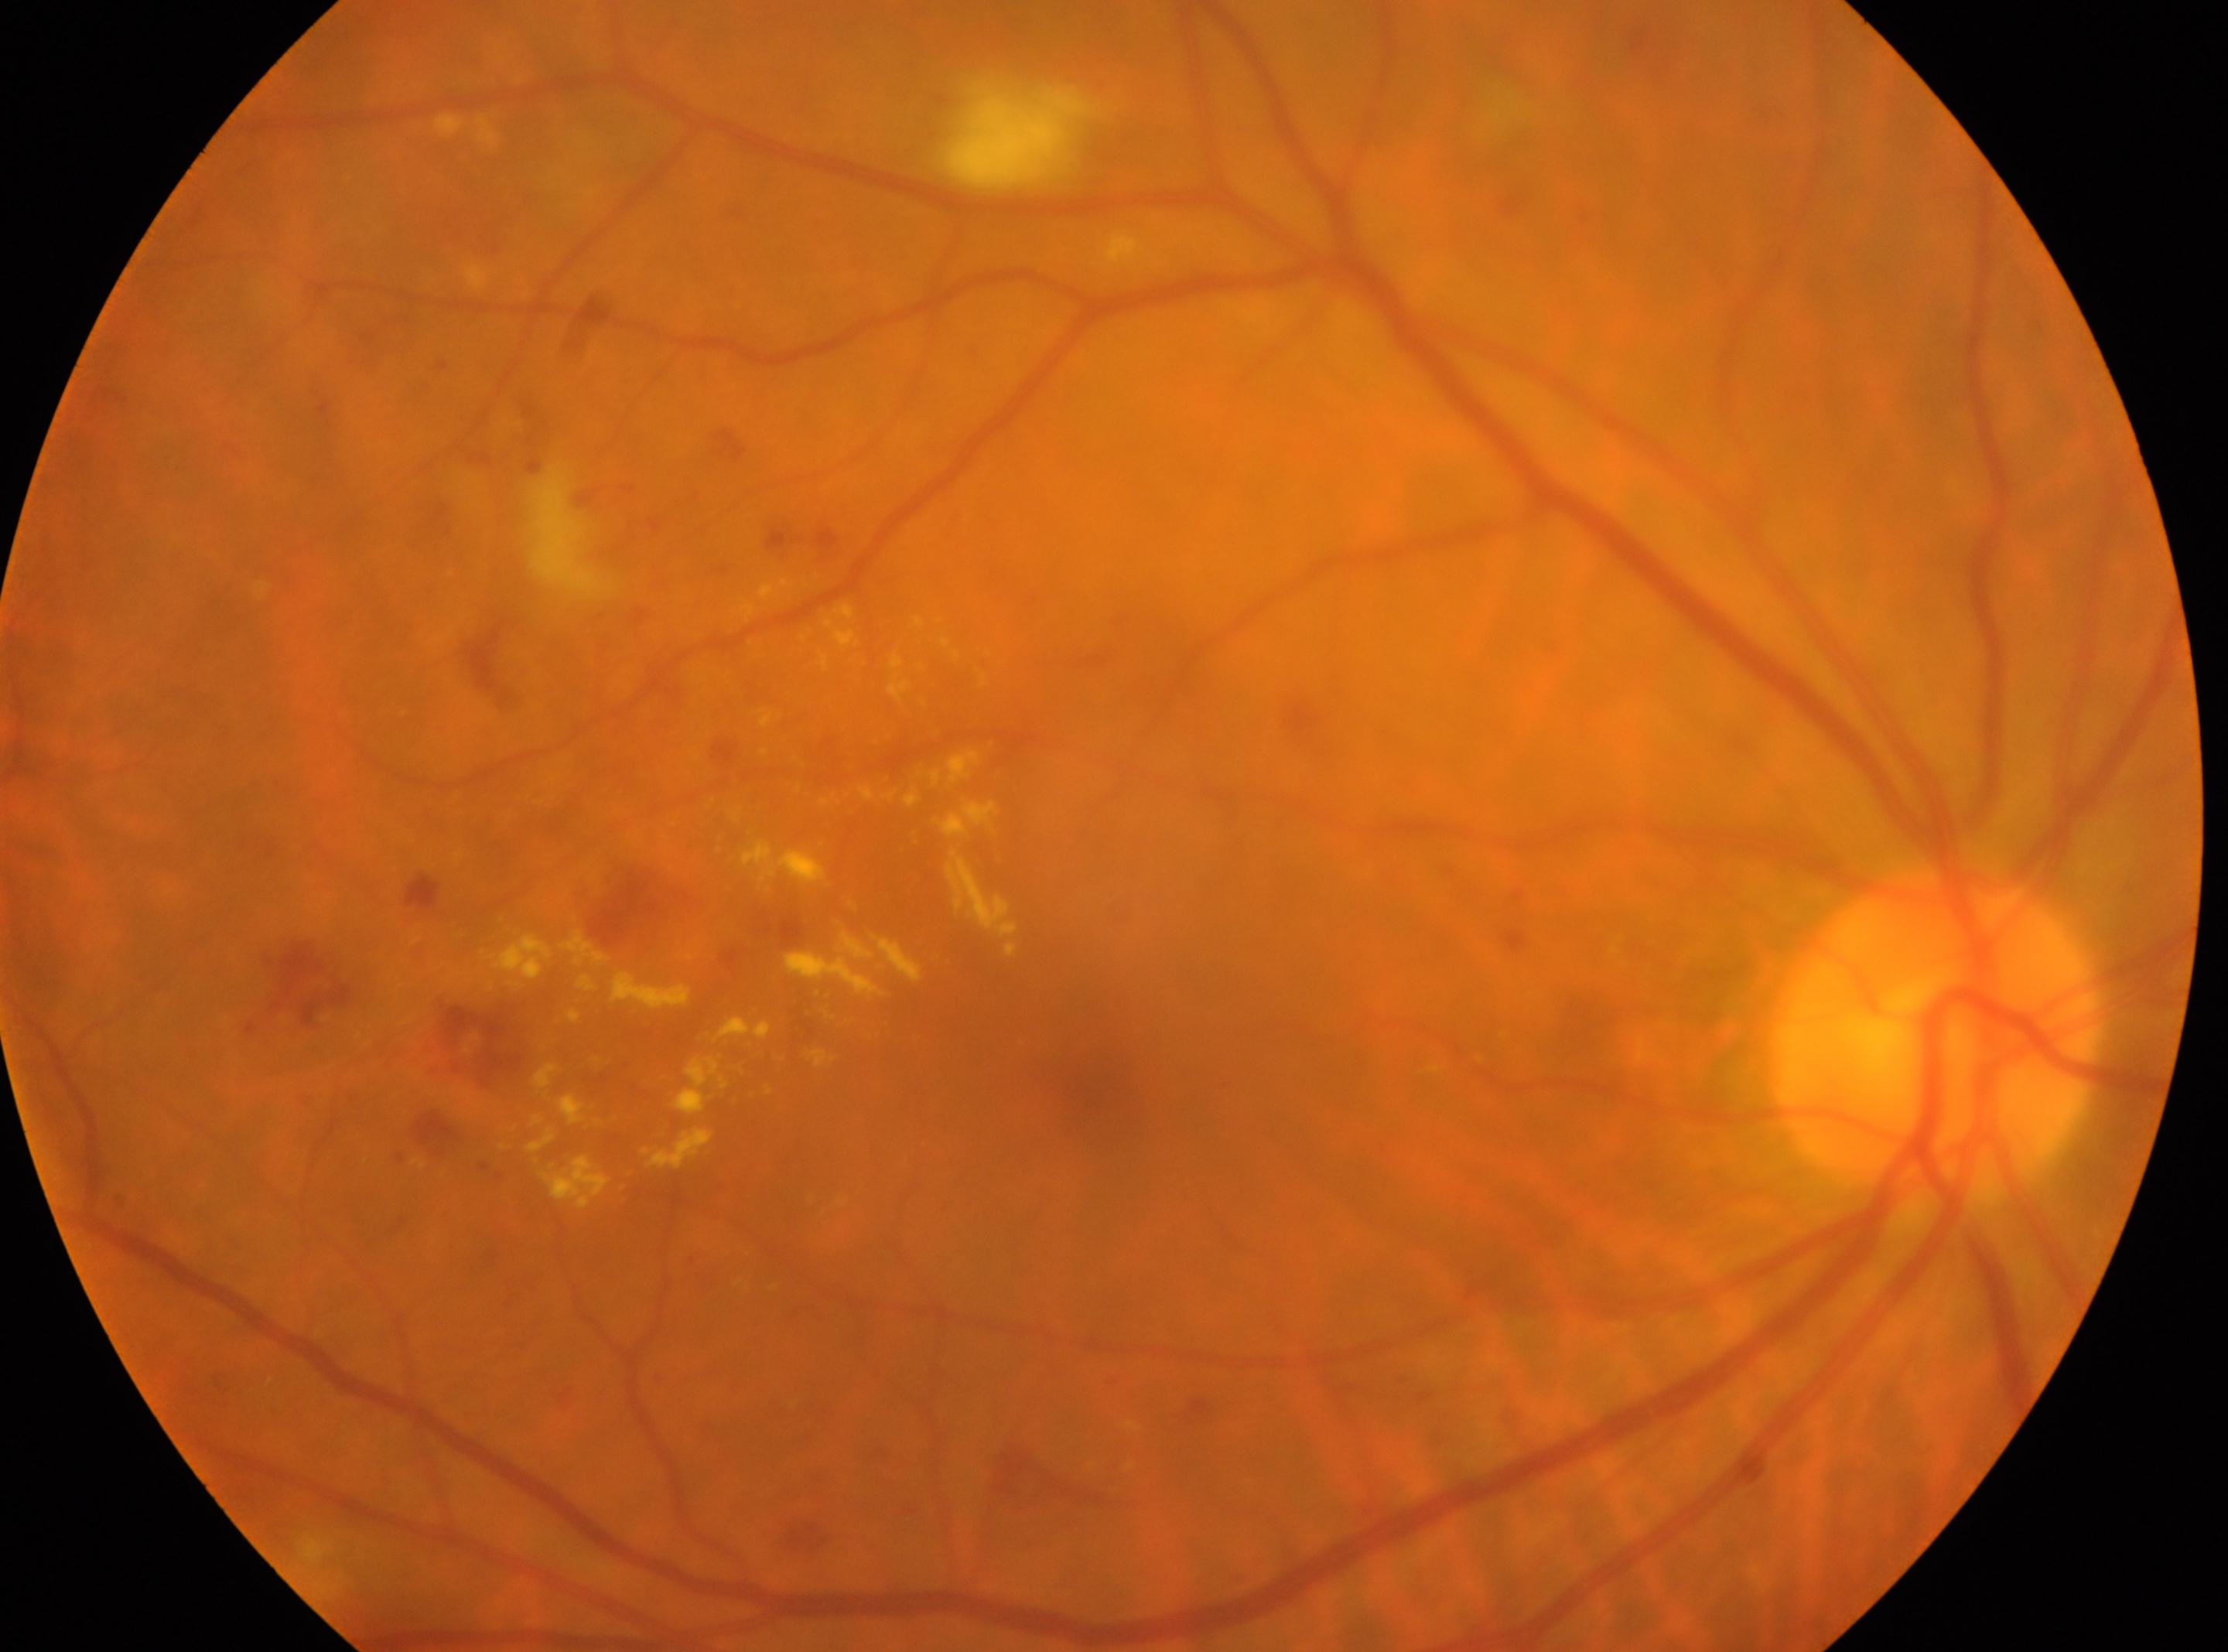

{"fovea": "1097px, 1084px", "eye": "the right eye", "optic_disc": "1931px, 1032px", "dr_grade": "2/4"}